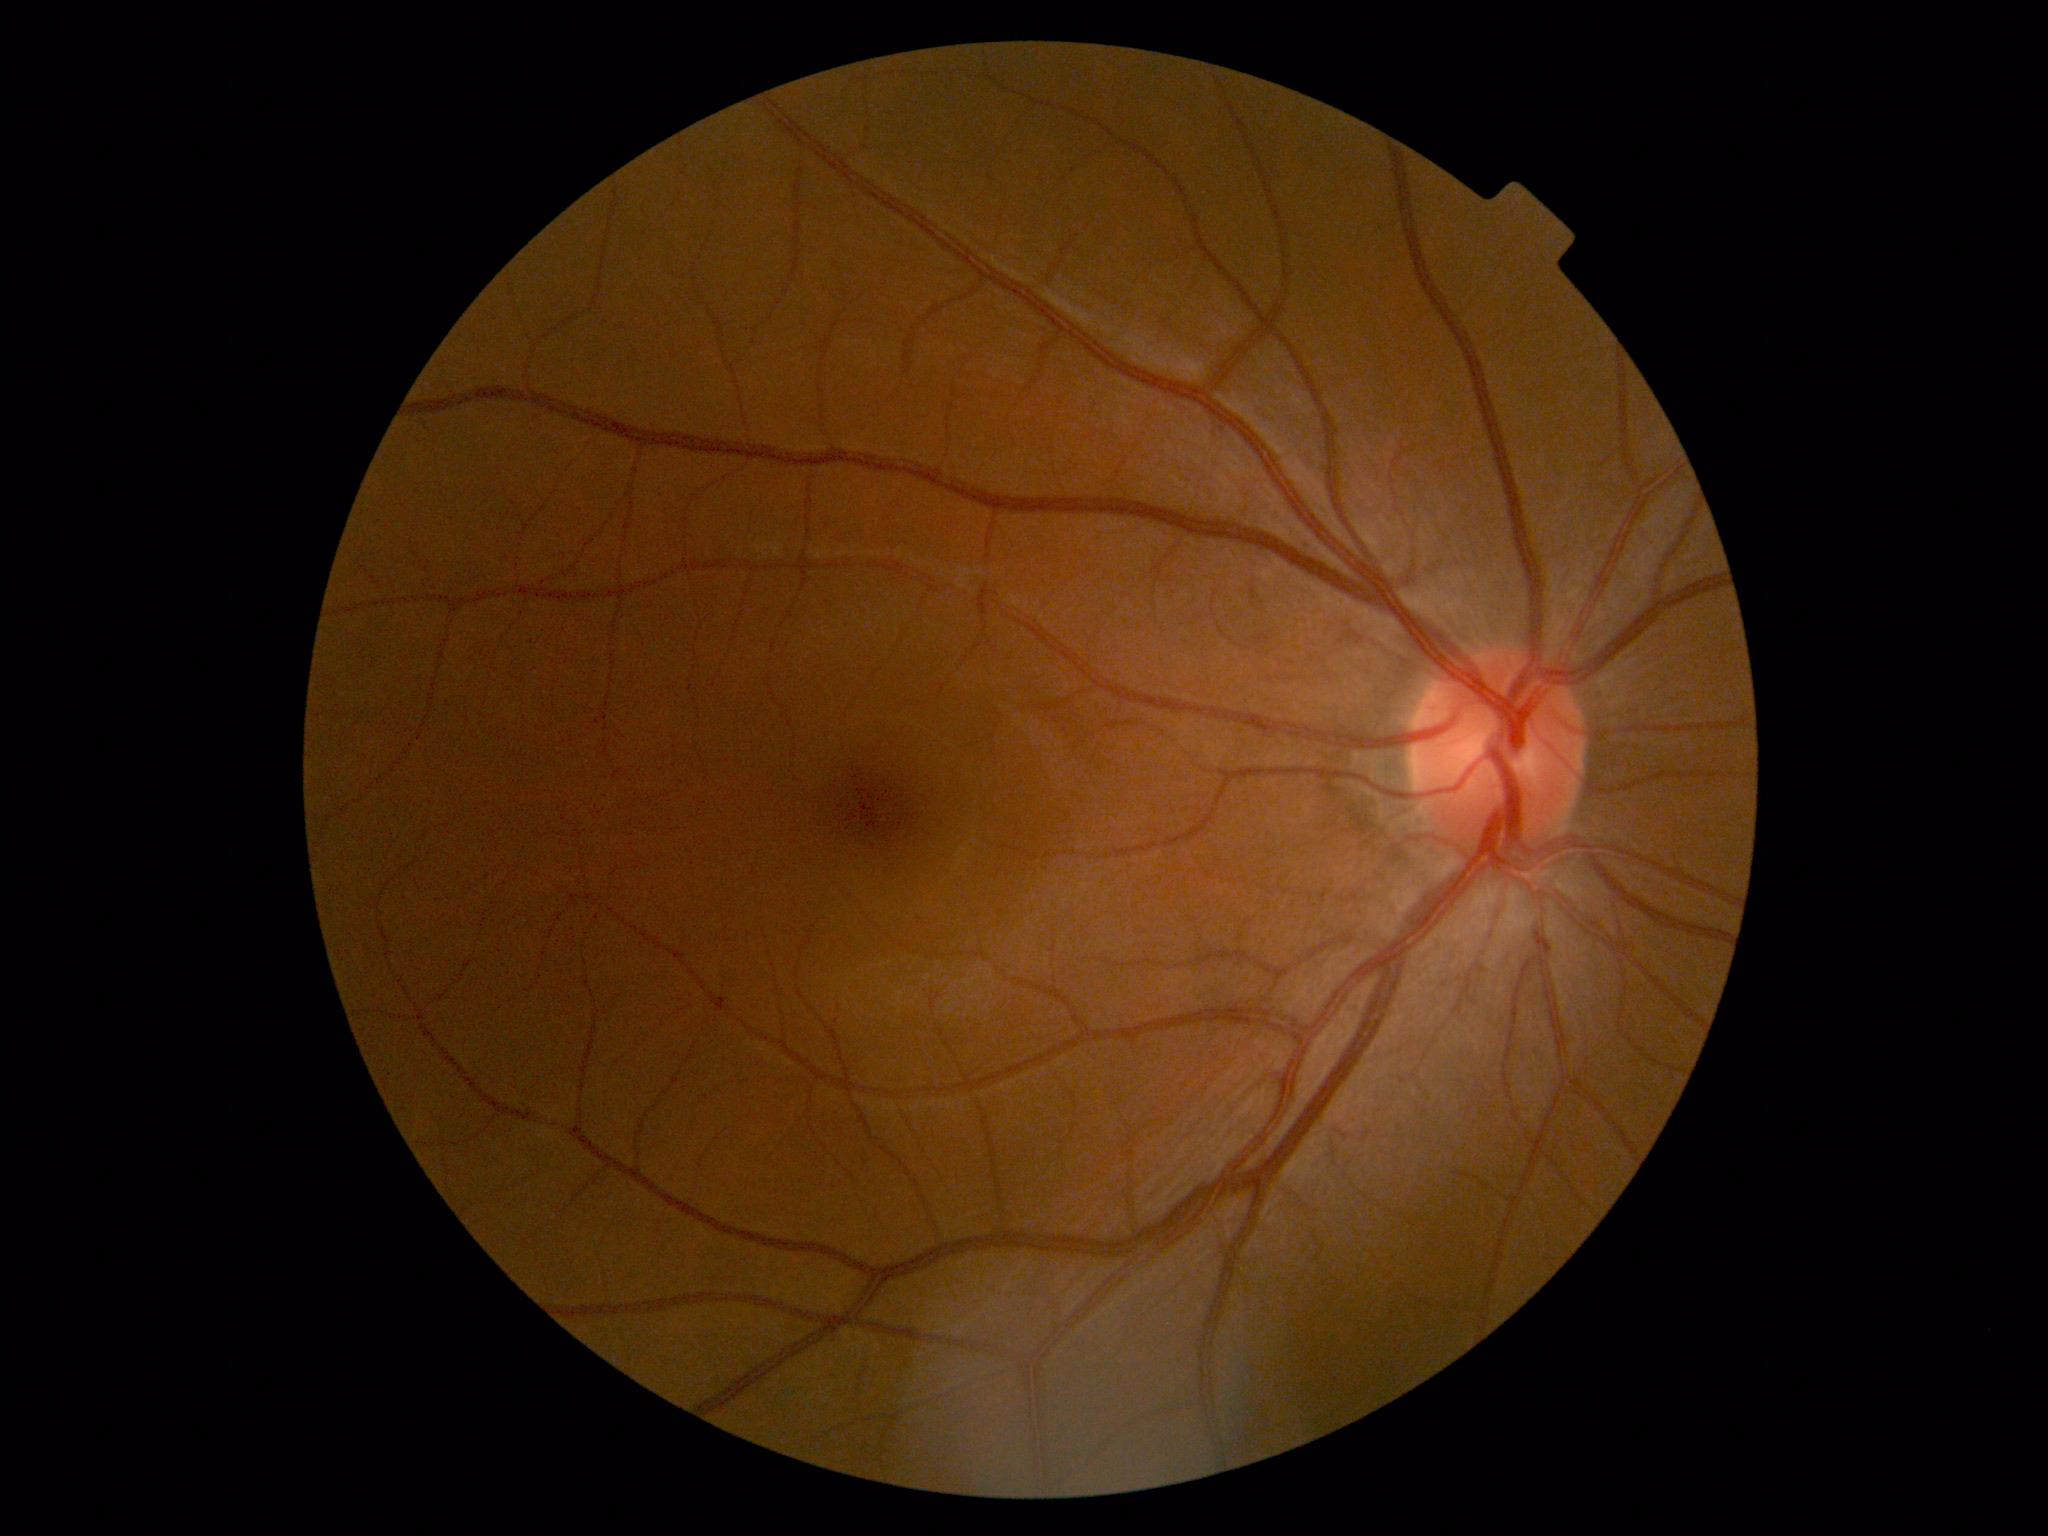 Diabetic retinopathy grade is no apparent diabetic retinopathy (0).